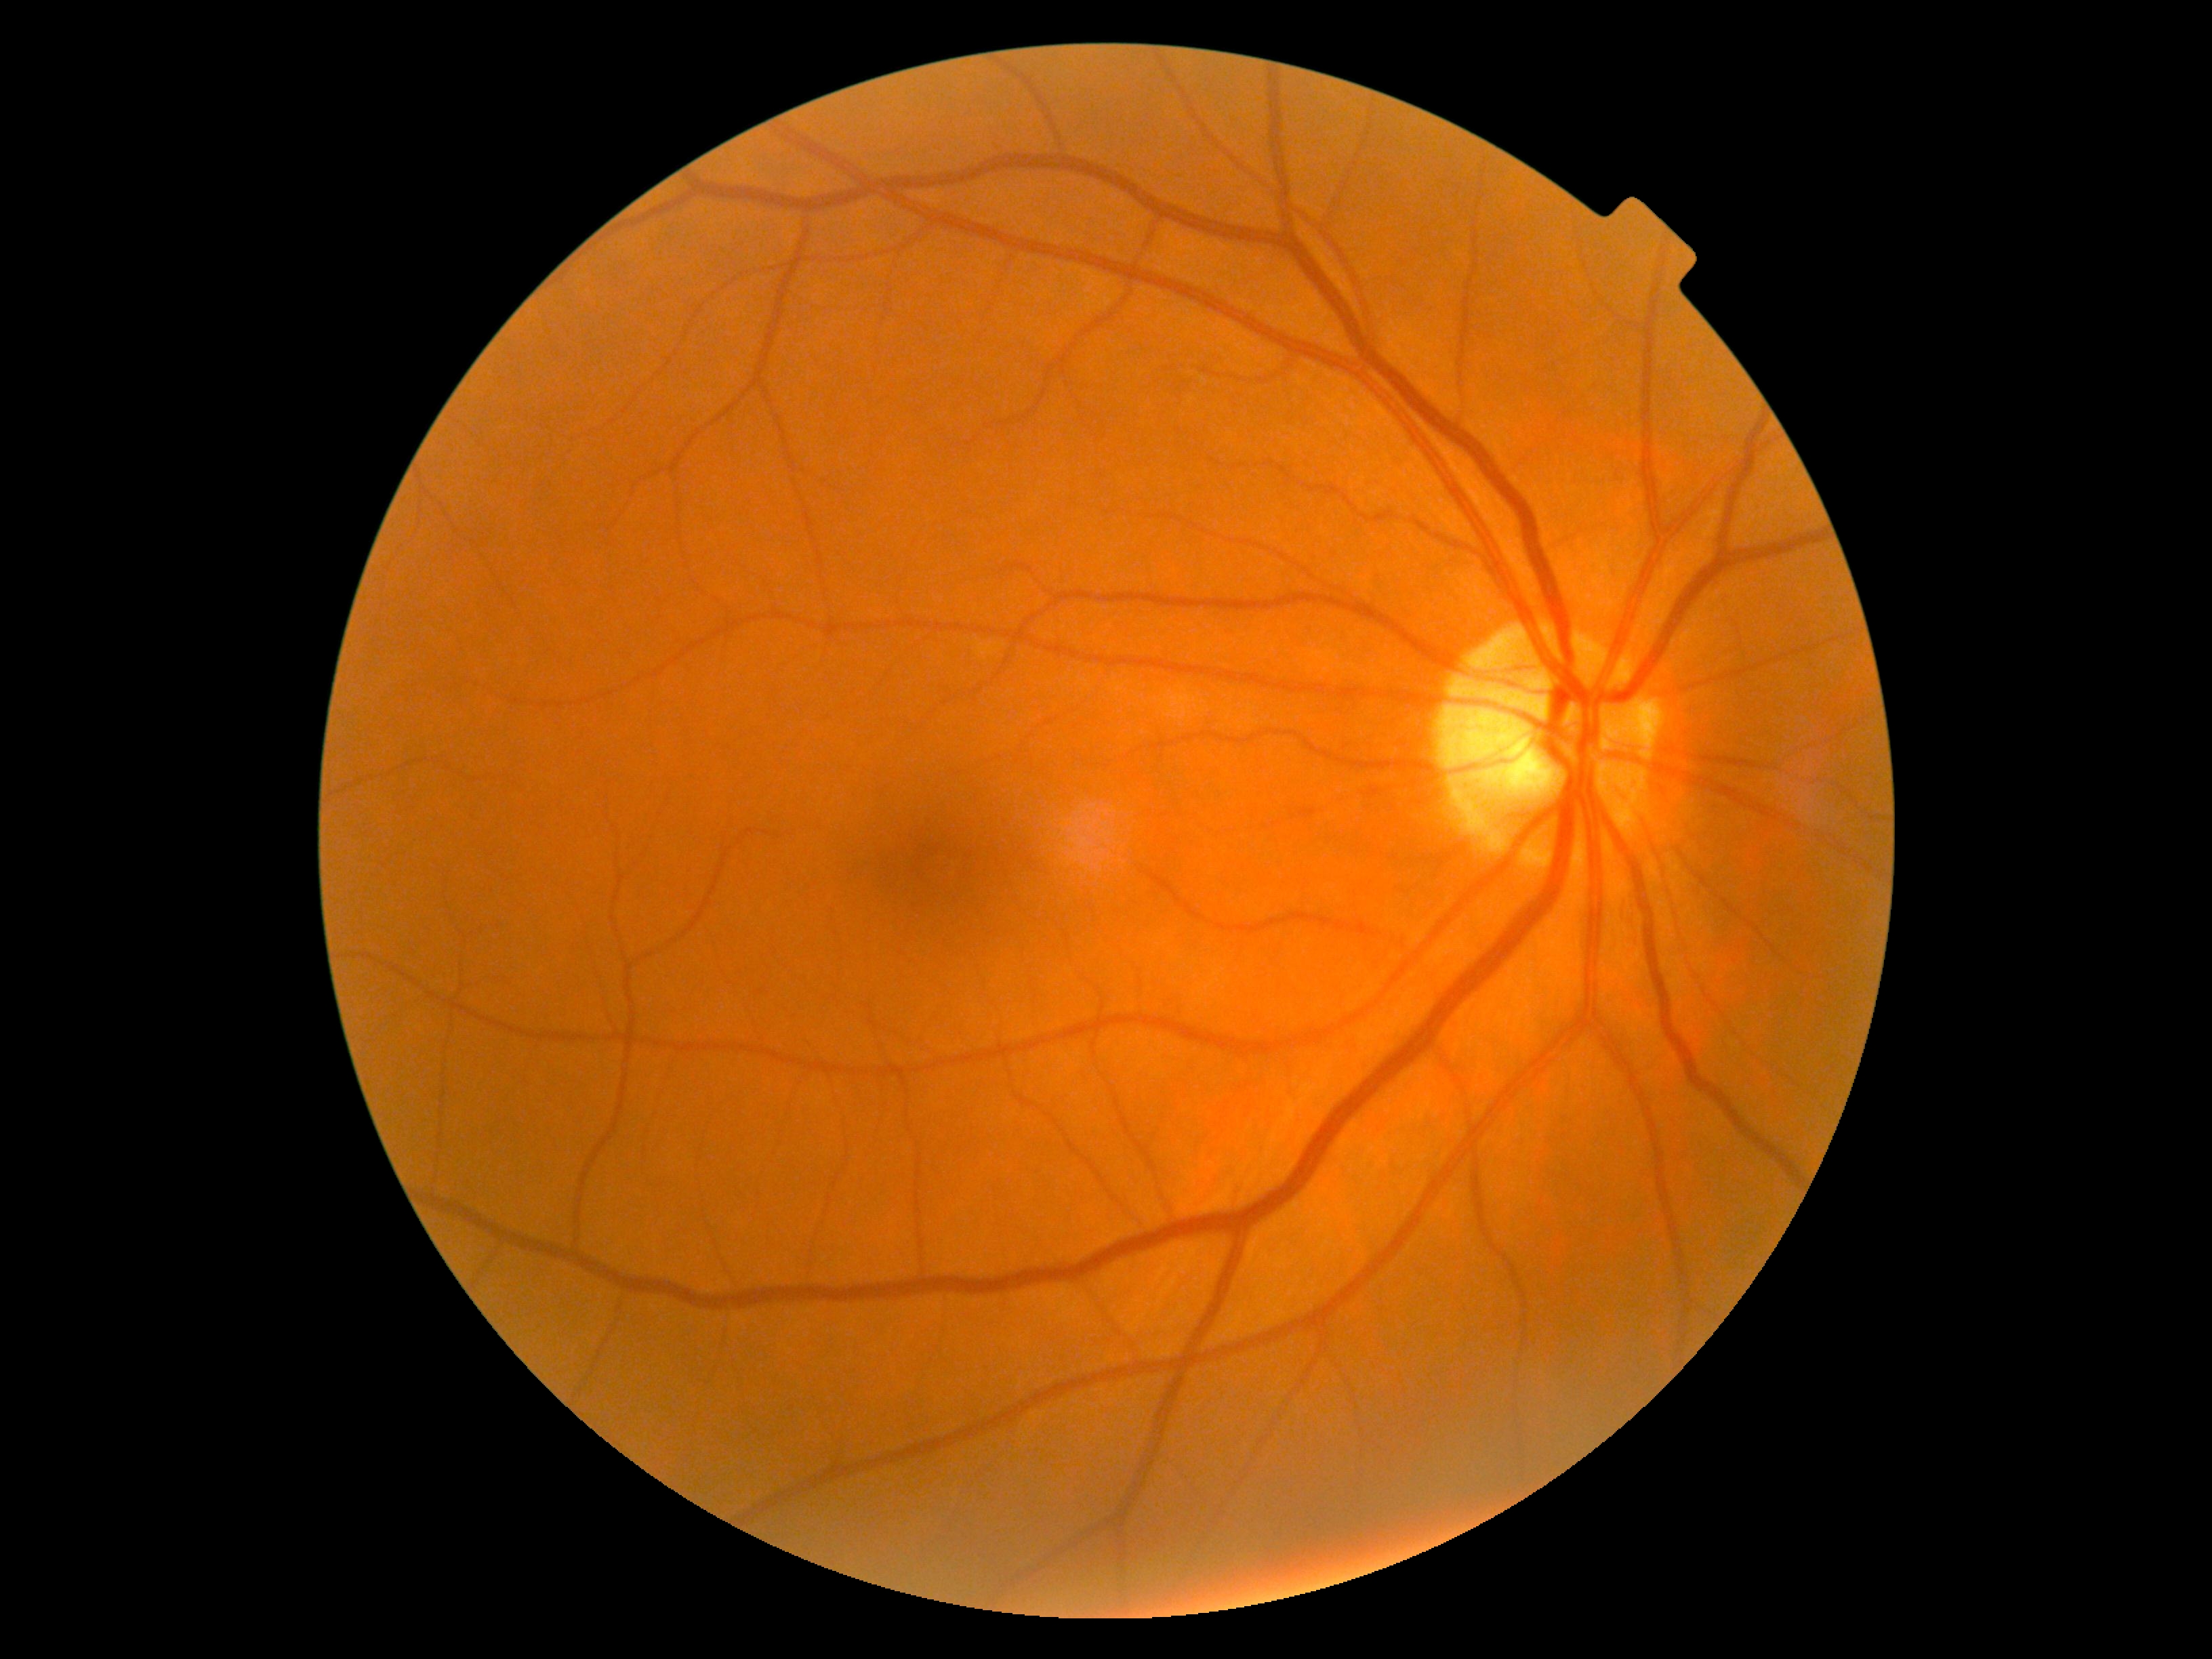
{"dr_grade": "0/4"}